45° field of view.
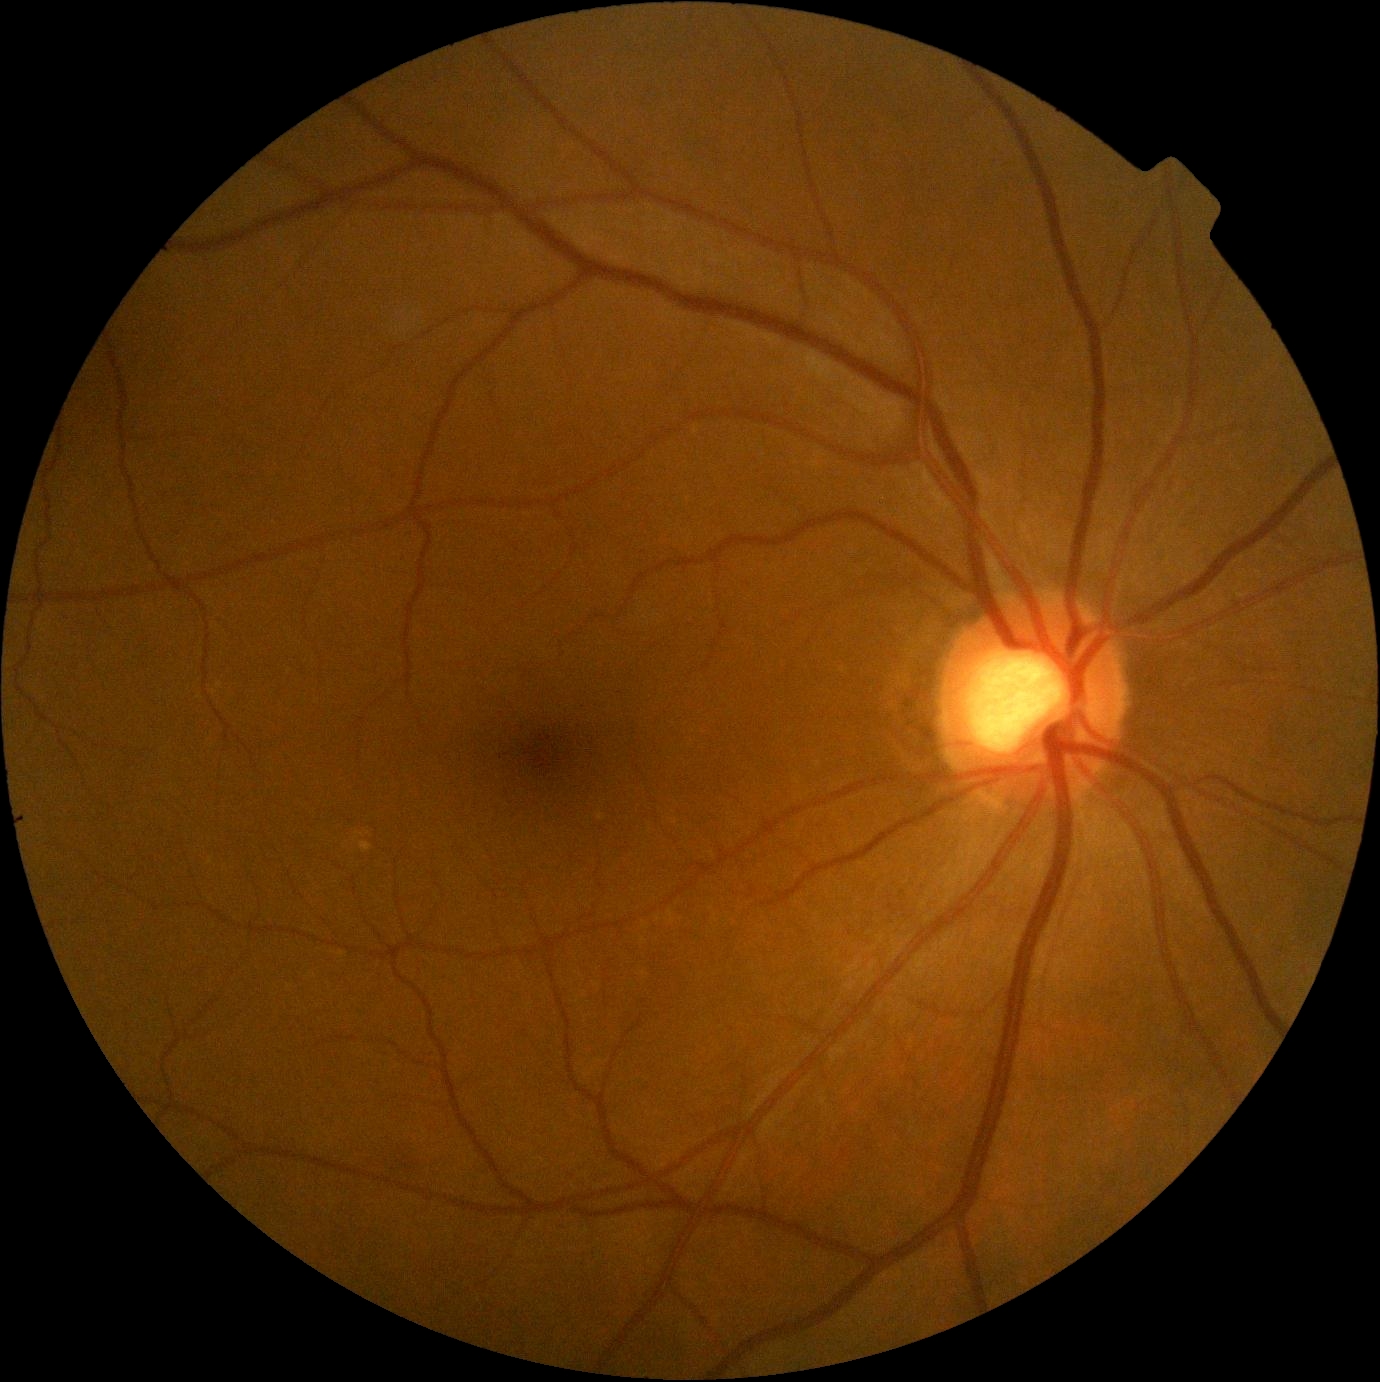
No diabetic retinal disease findings. DR grade: 0.